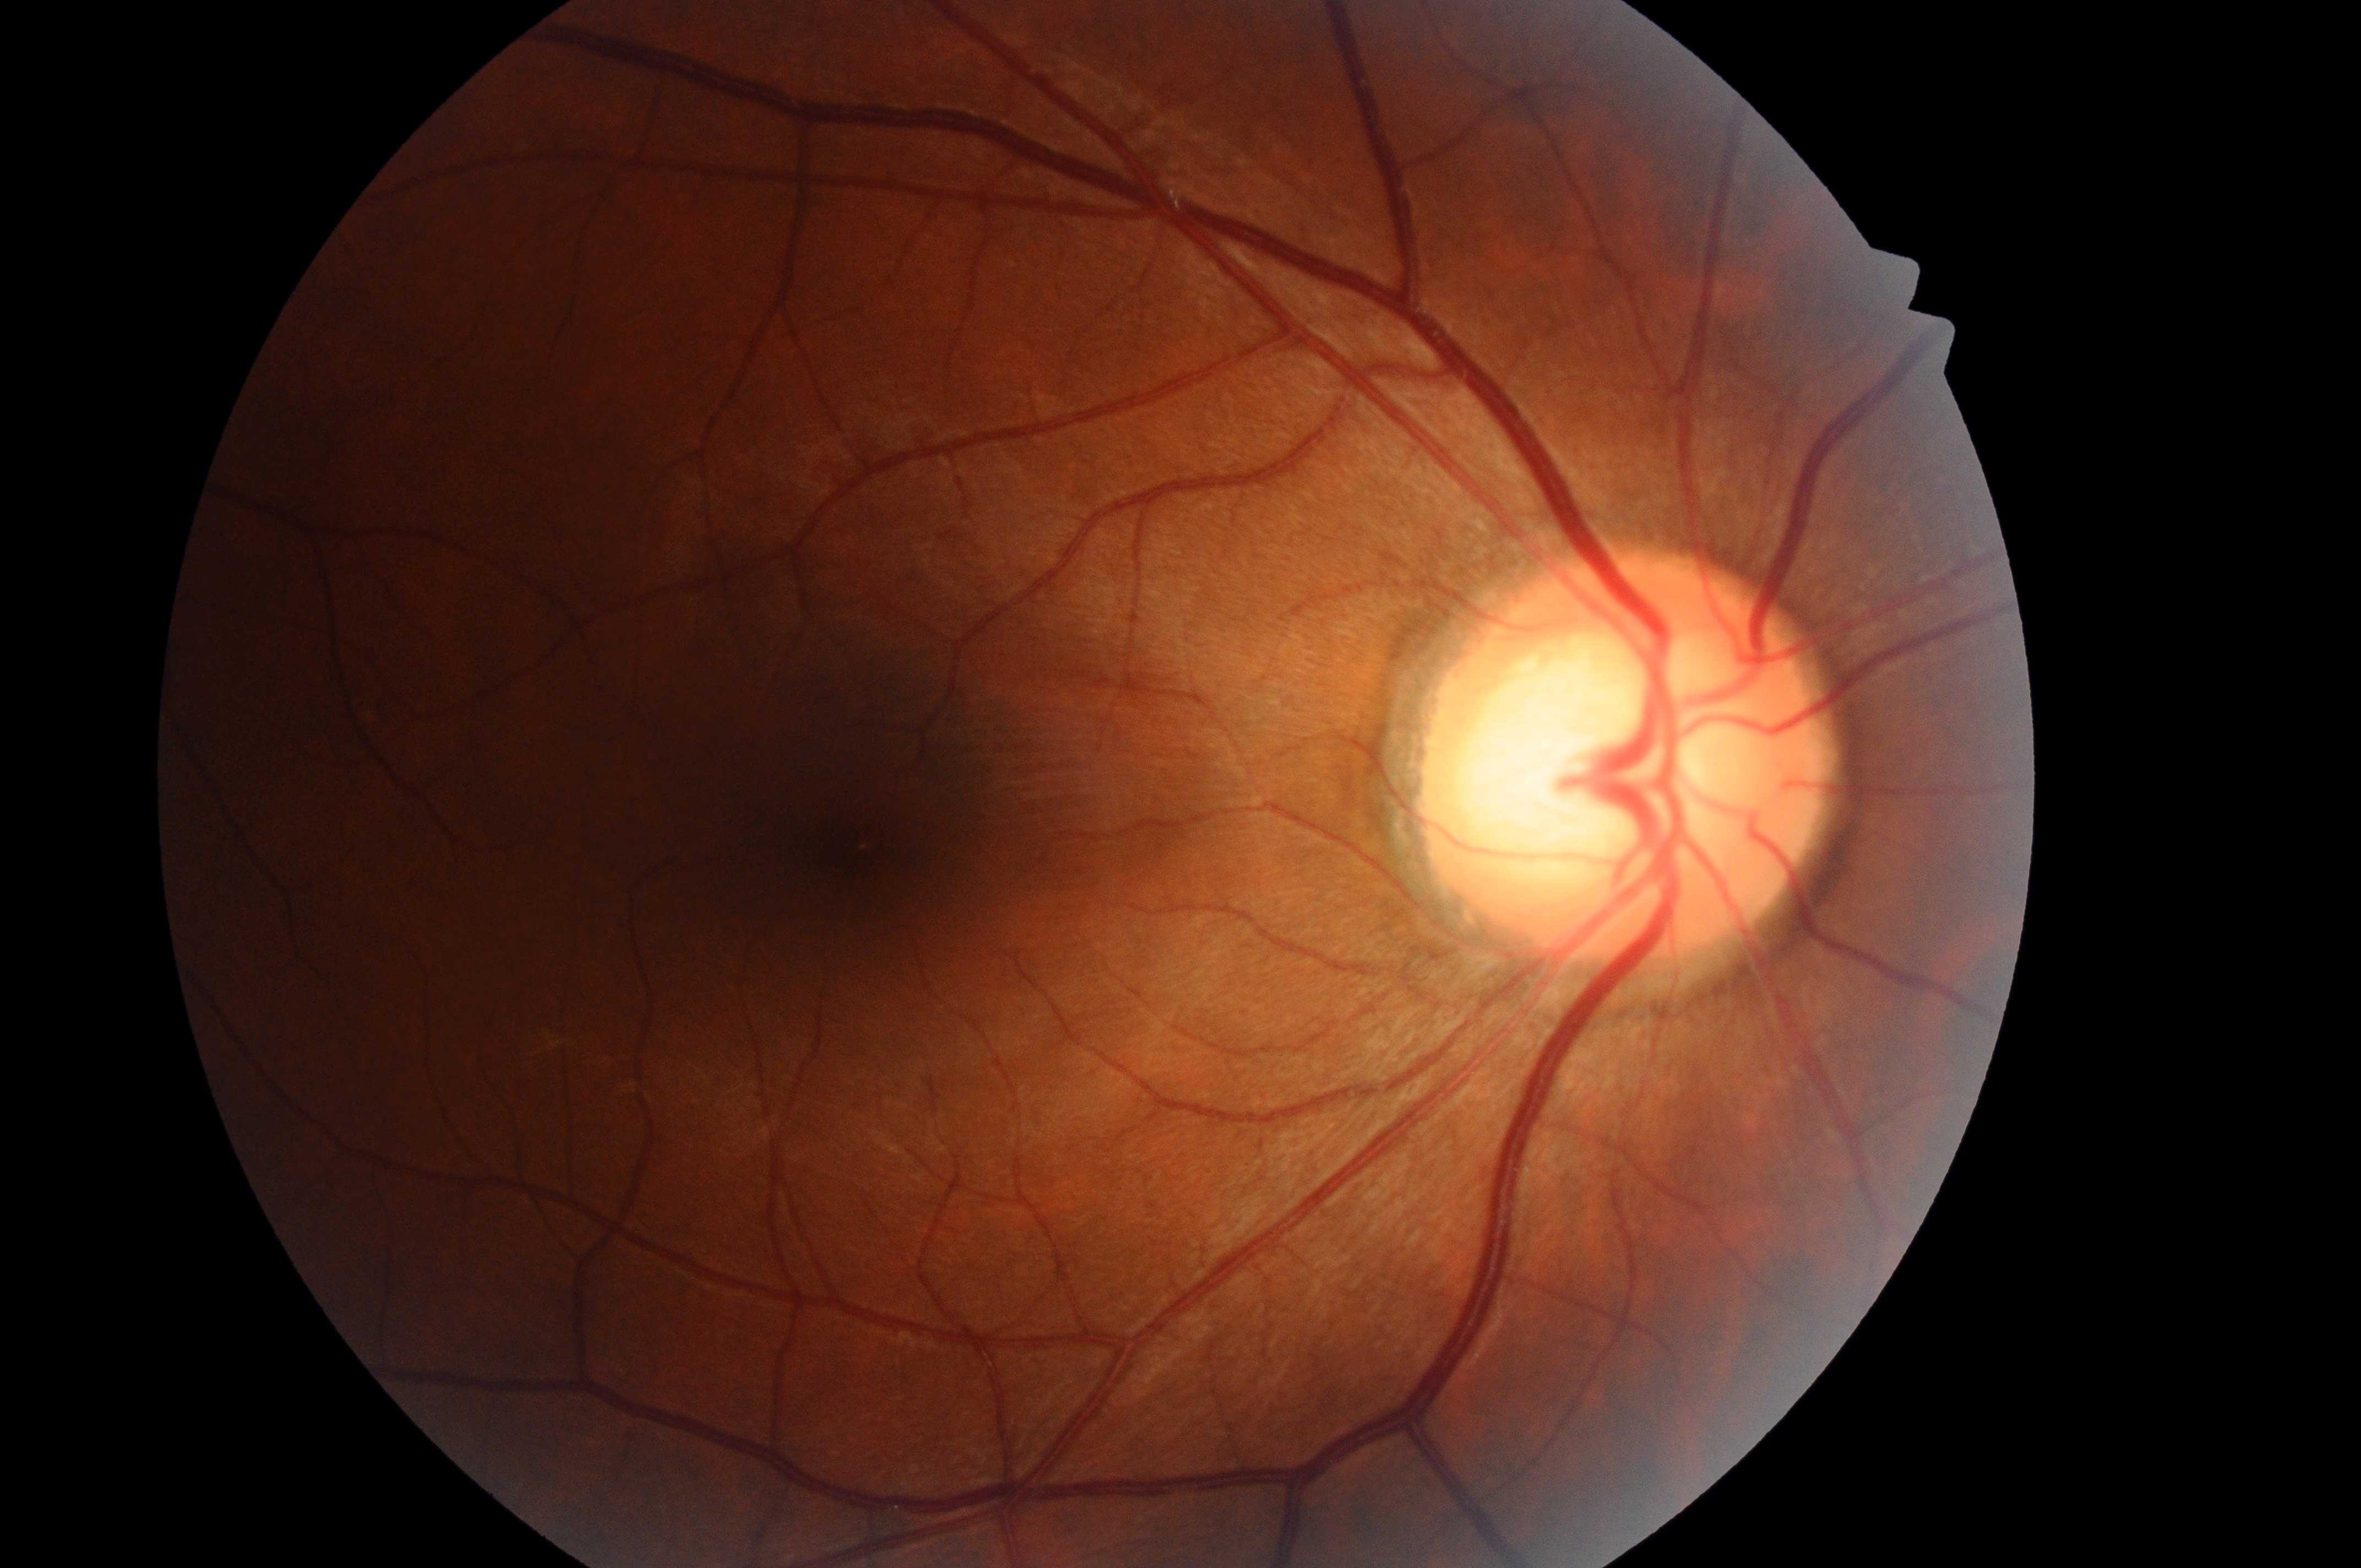

diabetic macular edema (DME) = 0 | diabetic retinopathy (DR) = 0 | DR impression = No apparent diabetic retinopathy or macular edema | disc center = (x=1622, y=775) | fovea centralis = (x=854, y=853) | laterality = oculus dexter.